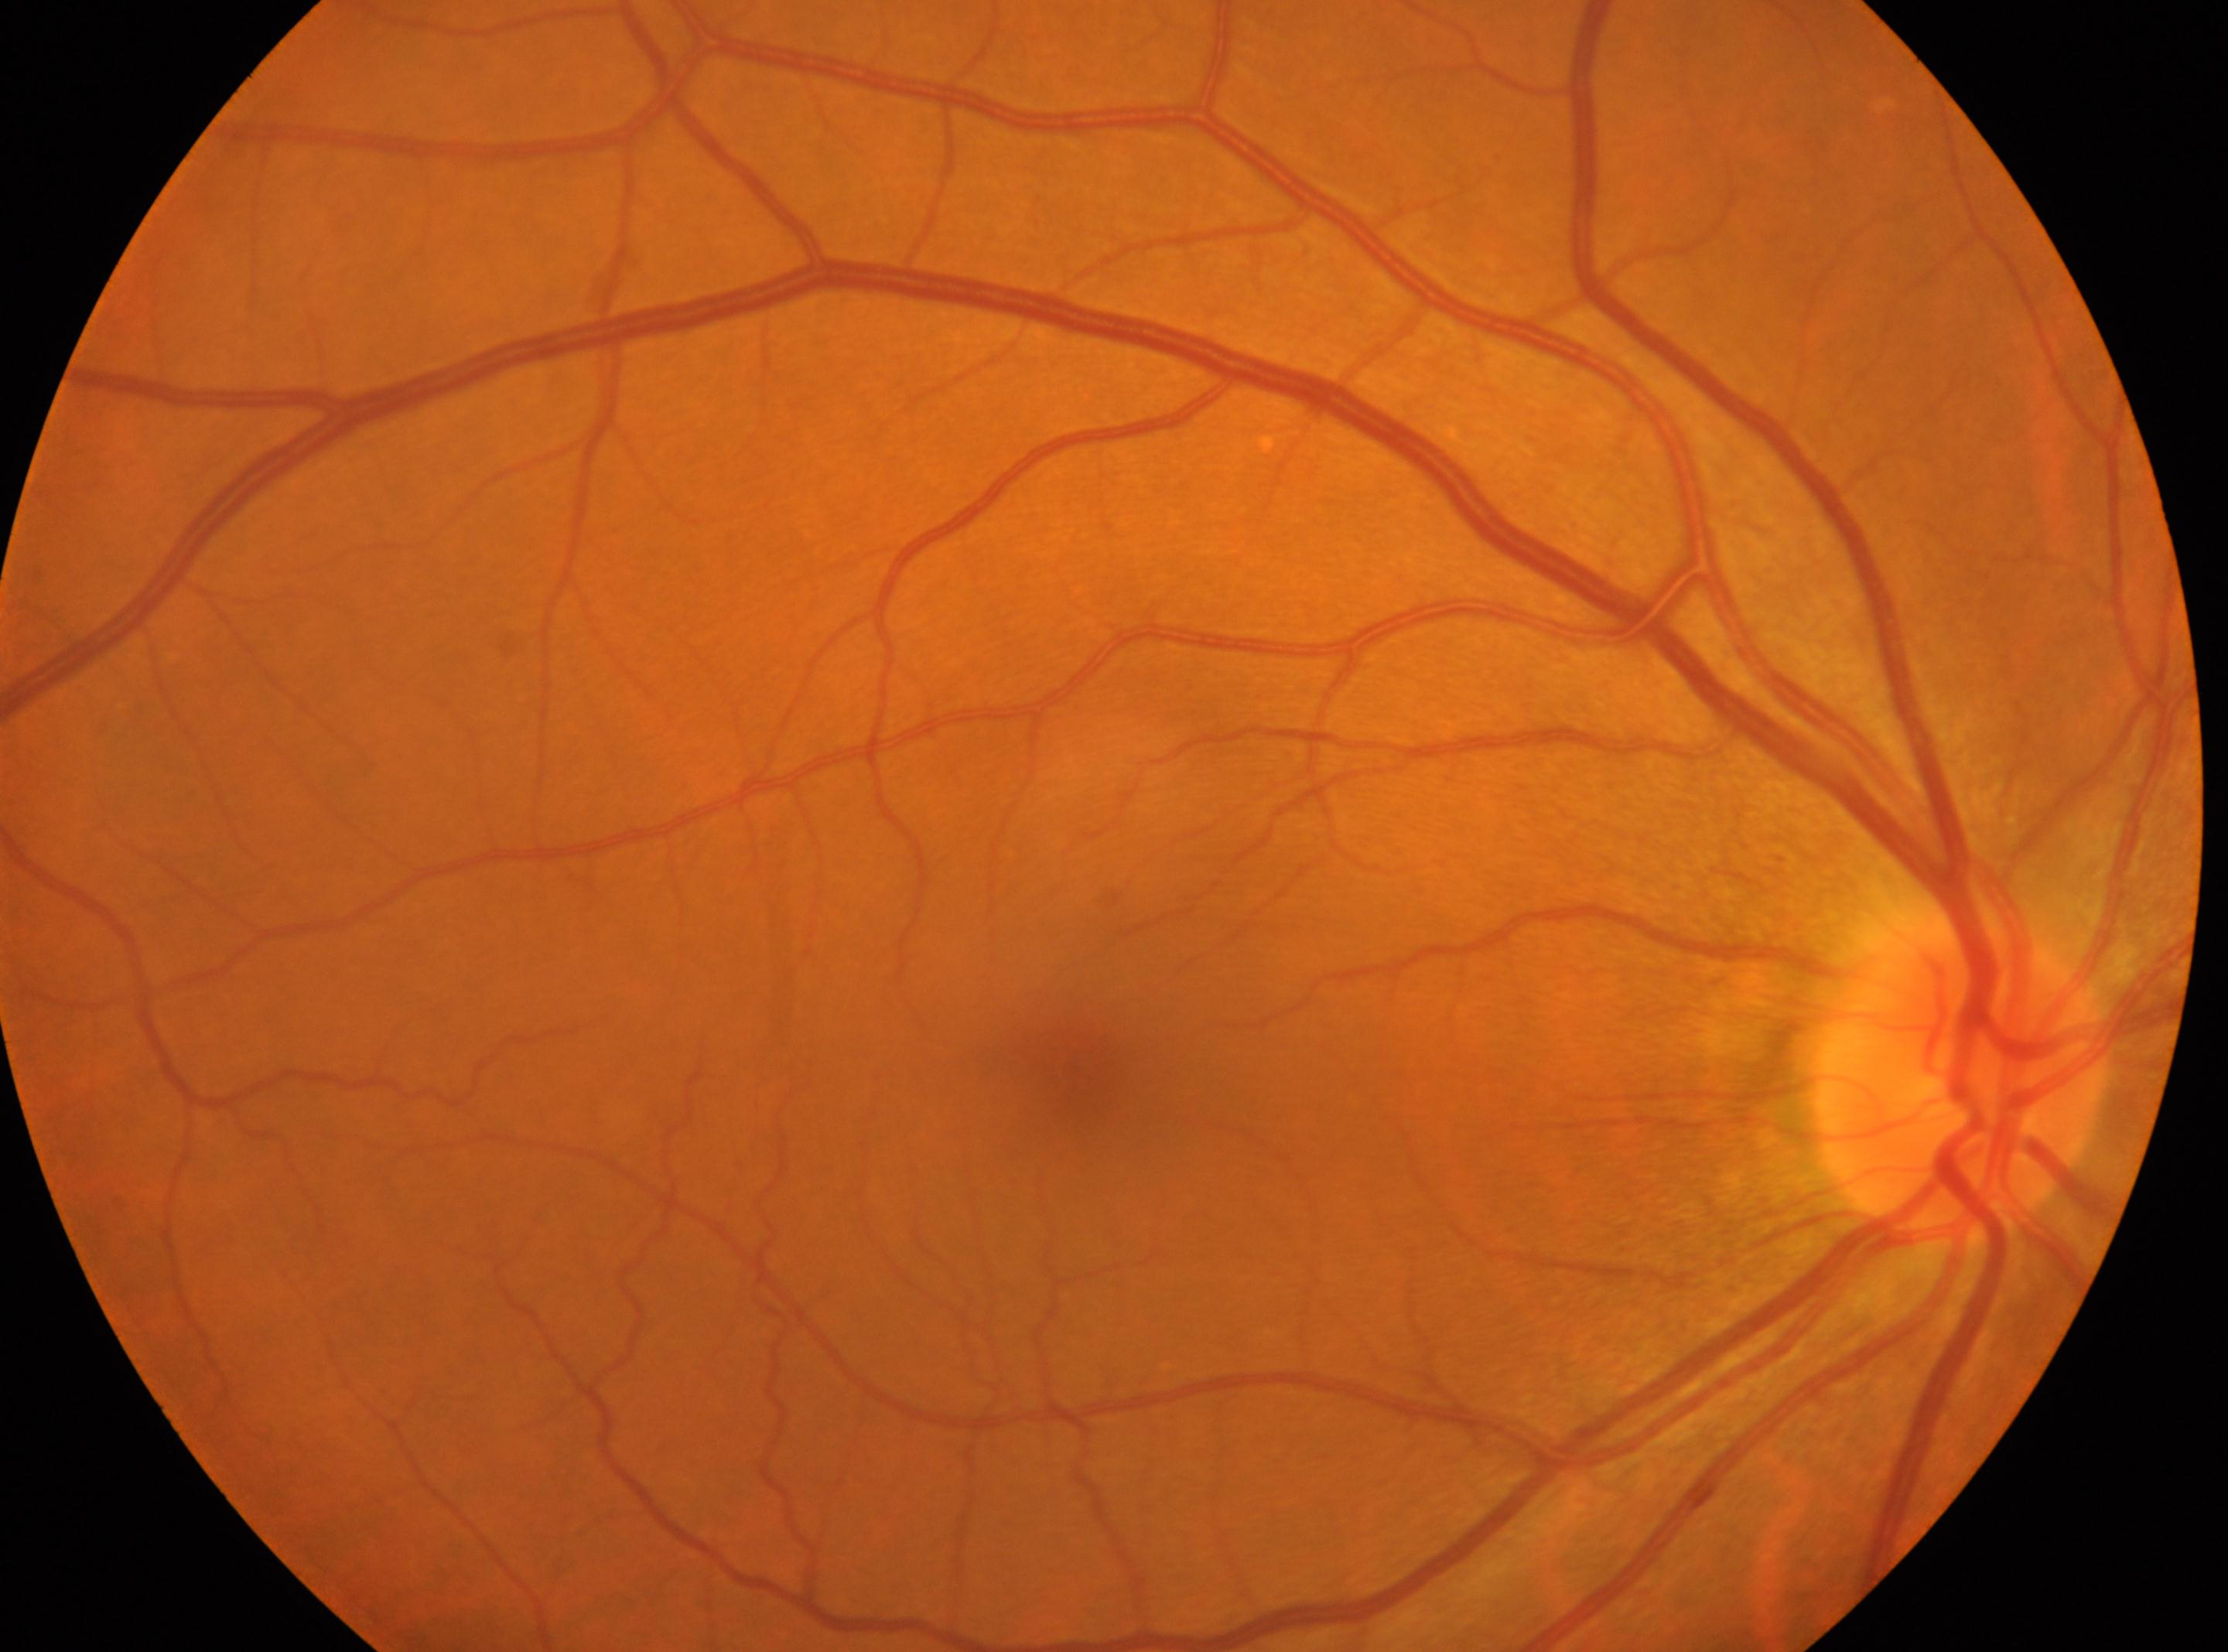
- disc center · (x=1955, y=1078)
- DR severity · grade 0
- laterality · right eye
- DR impression · No diabetic retinopathy identified
- macular center · (x=1077, y=1066)